Retinal fundus photograph. 2352x1568 — 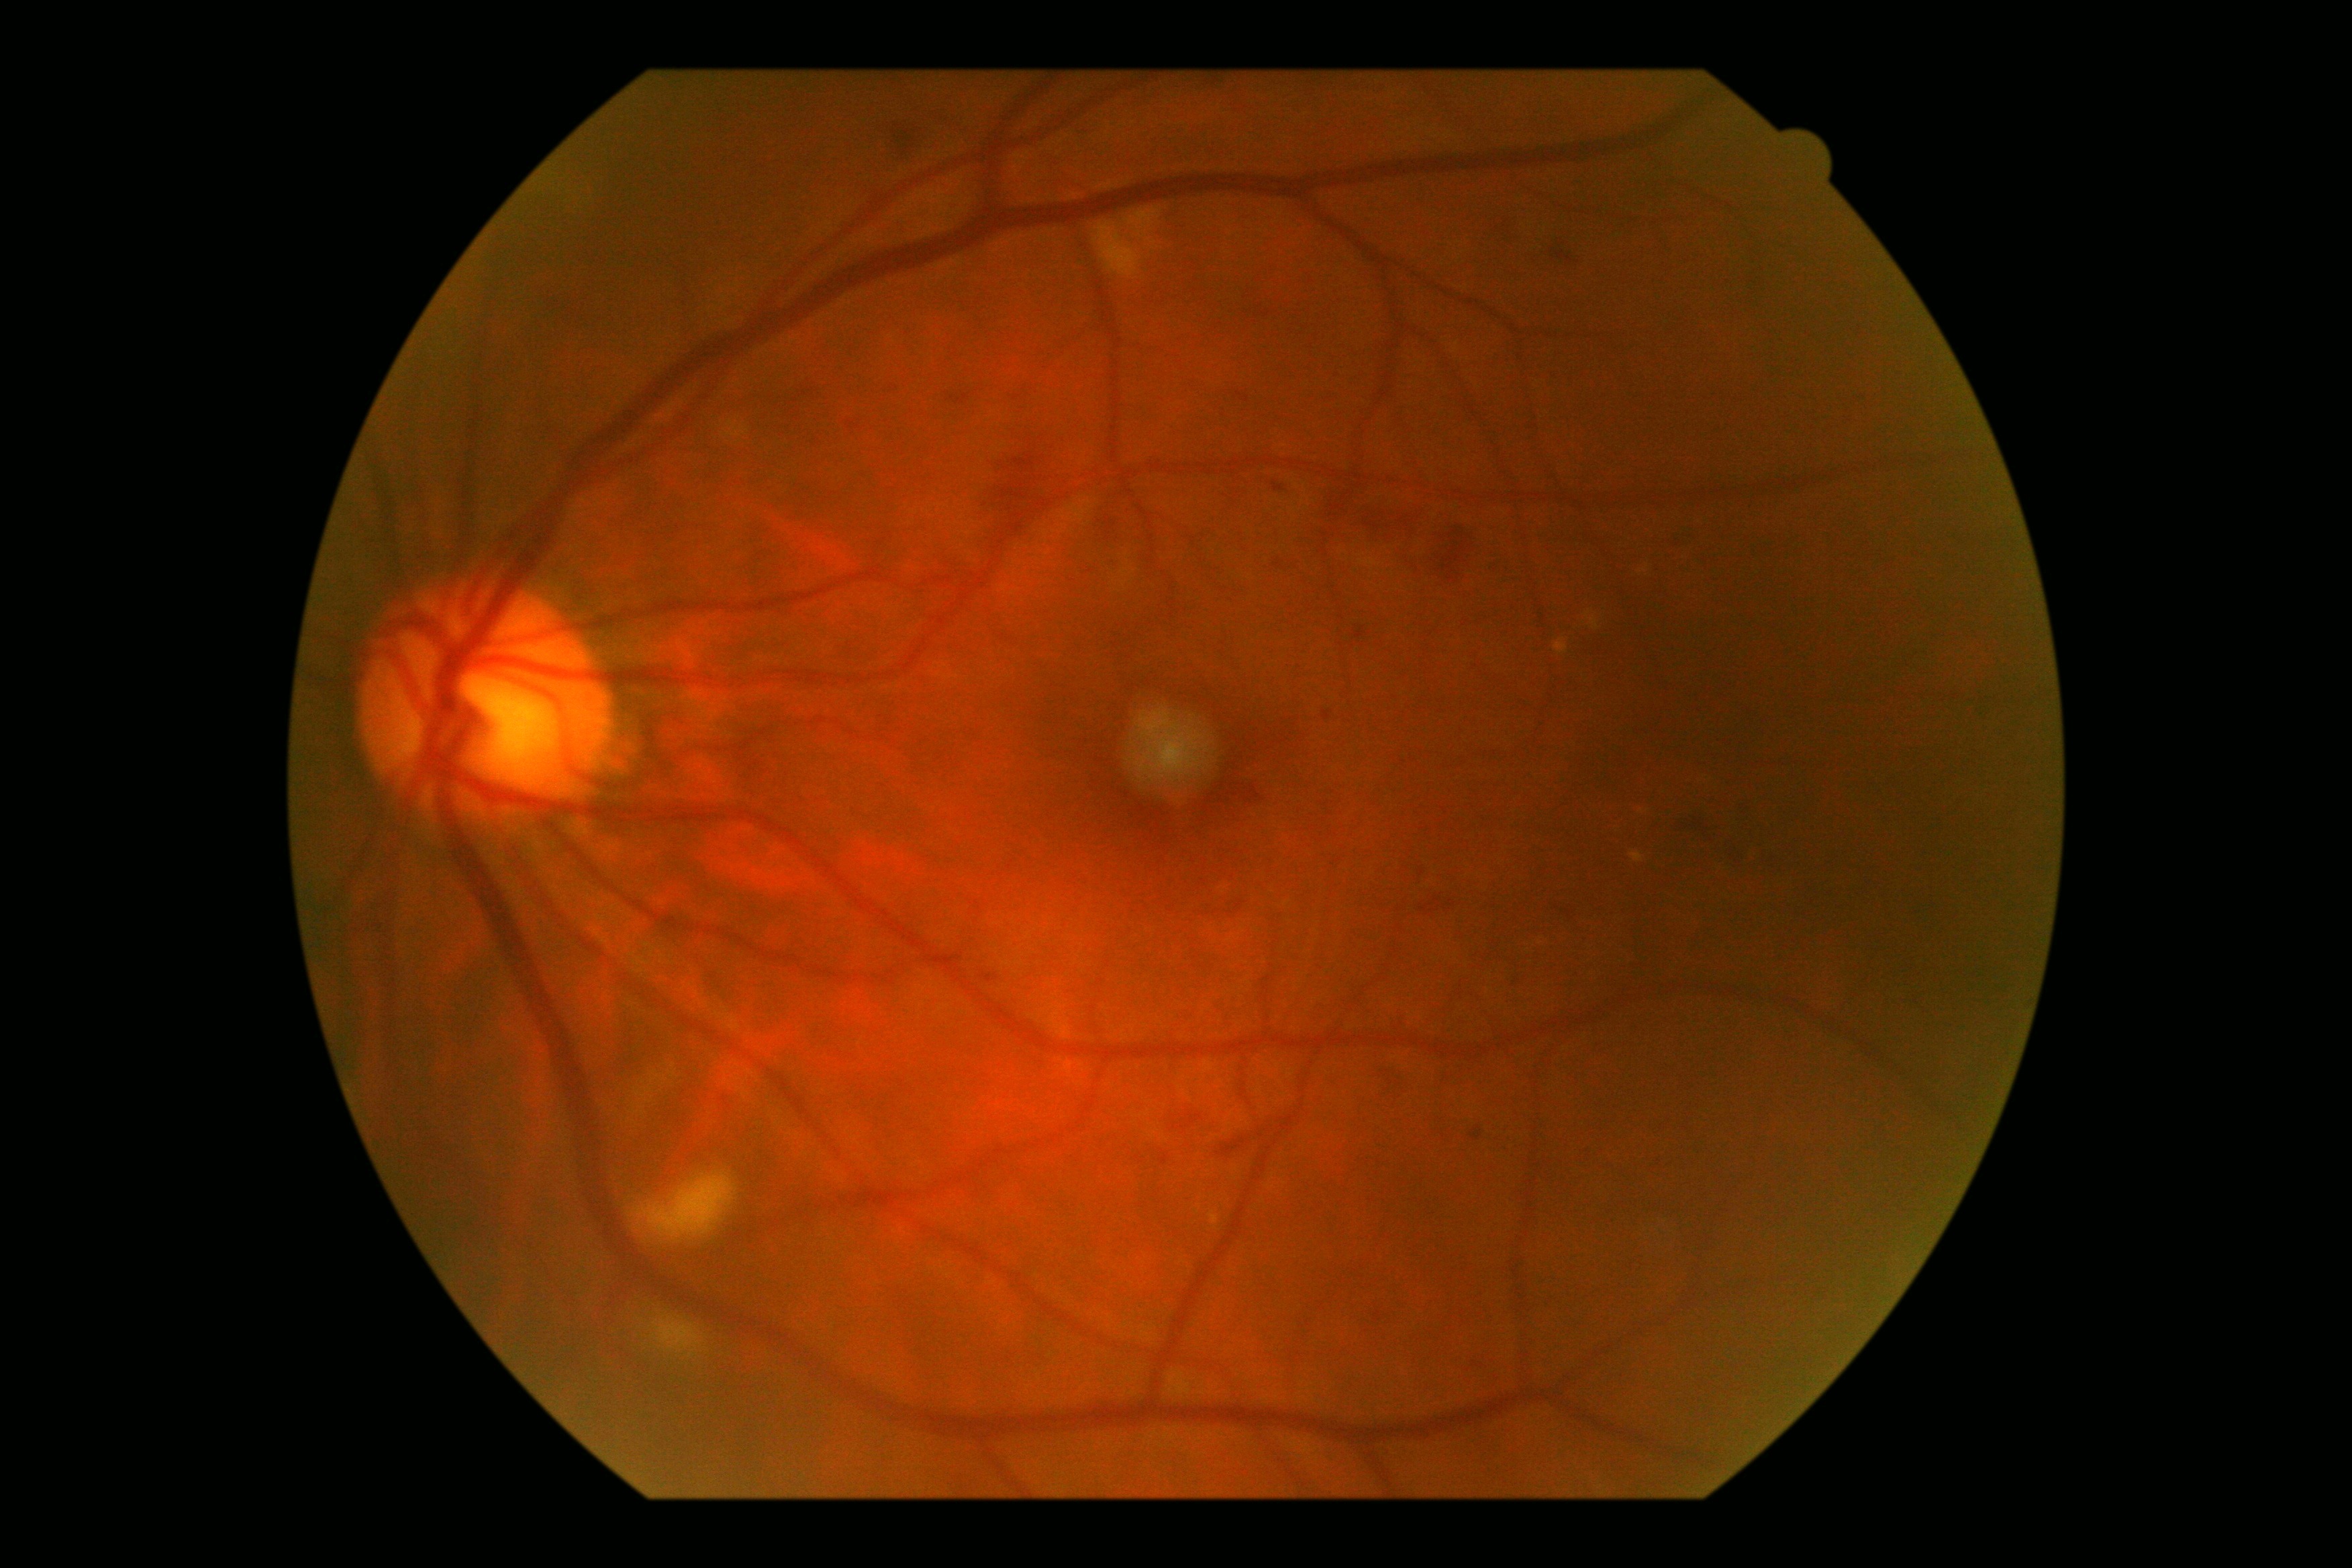
dr_grade: moderate non-proliferative diabetic retinopathy (grade 2)